45 degree fundus photograph.
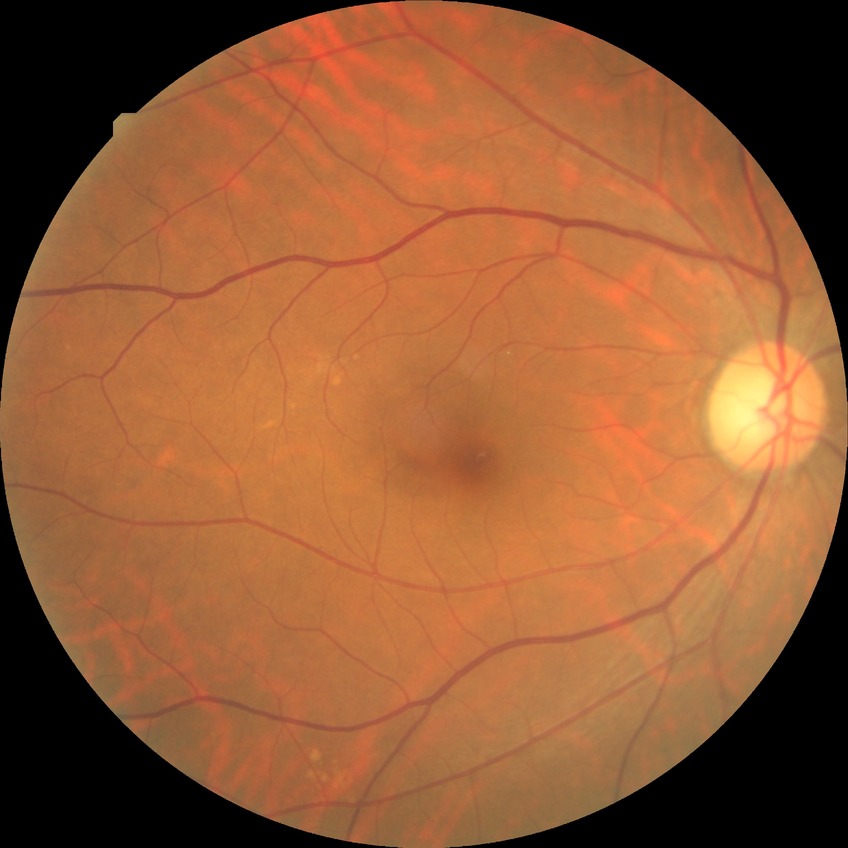

Diabetic retinopathy (DR) is NDR (no diabetic retinopathy).